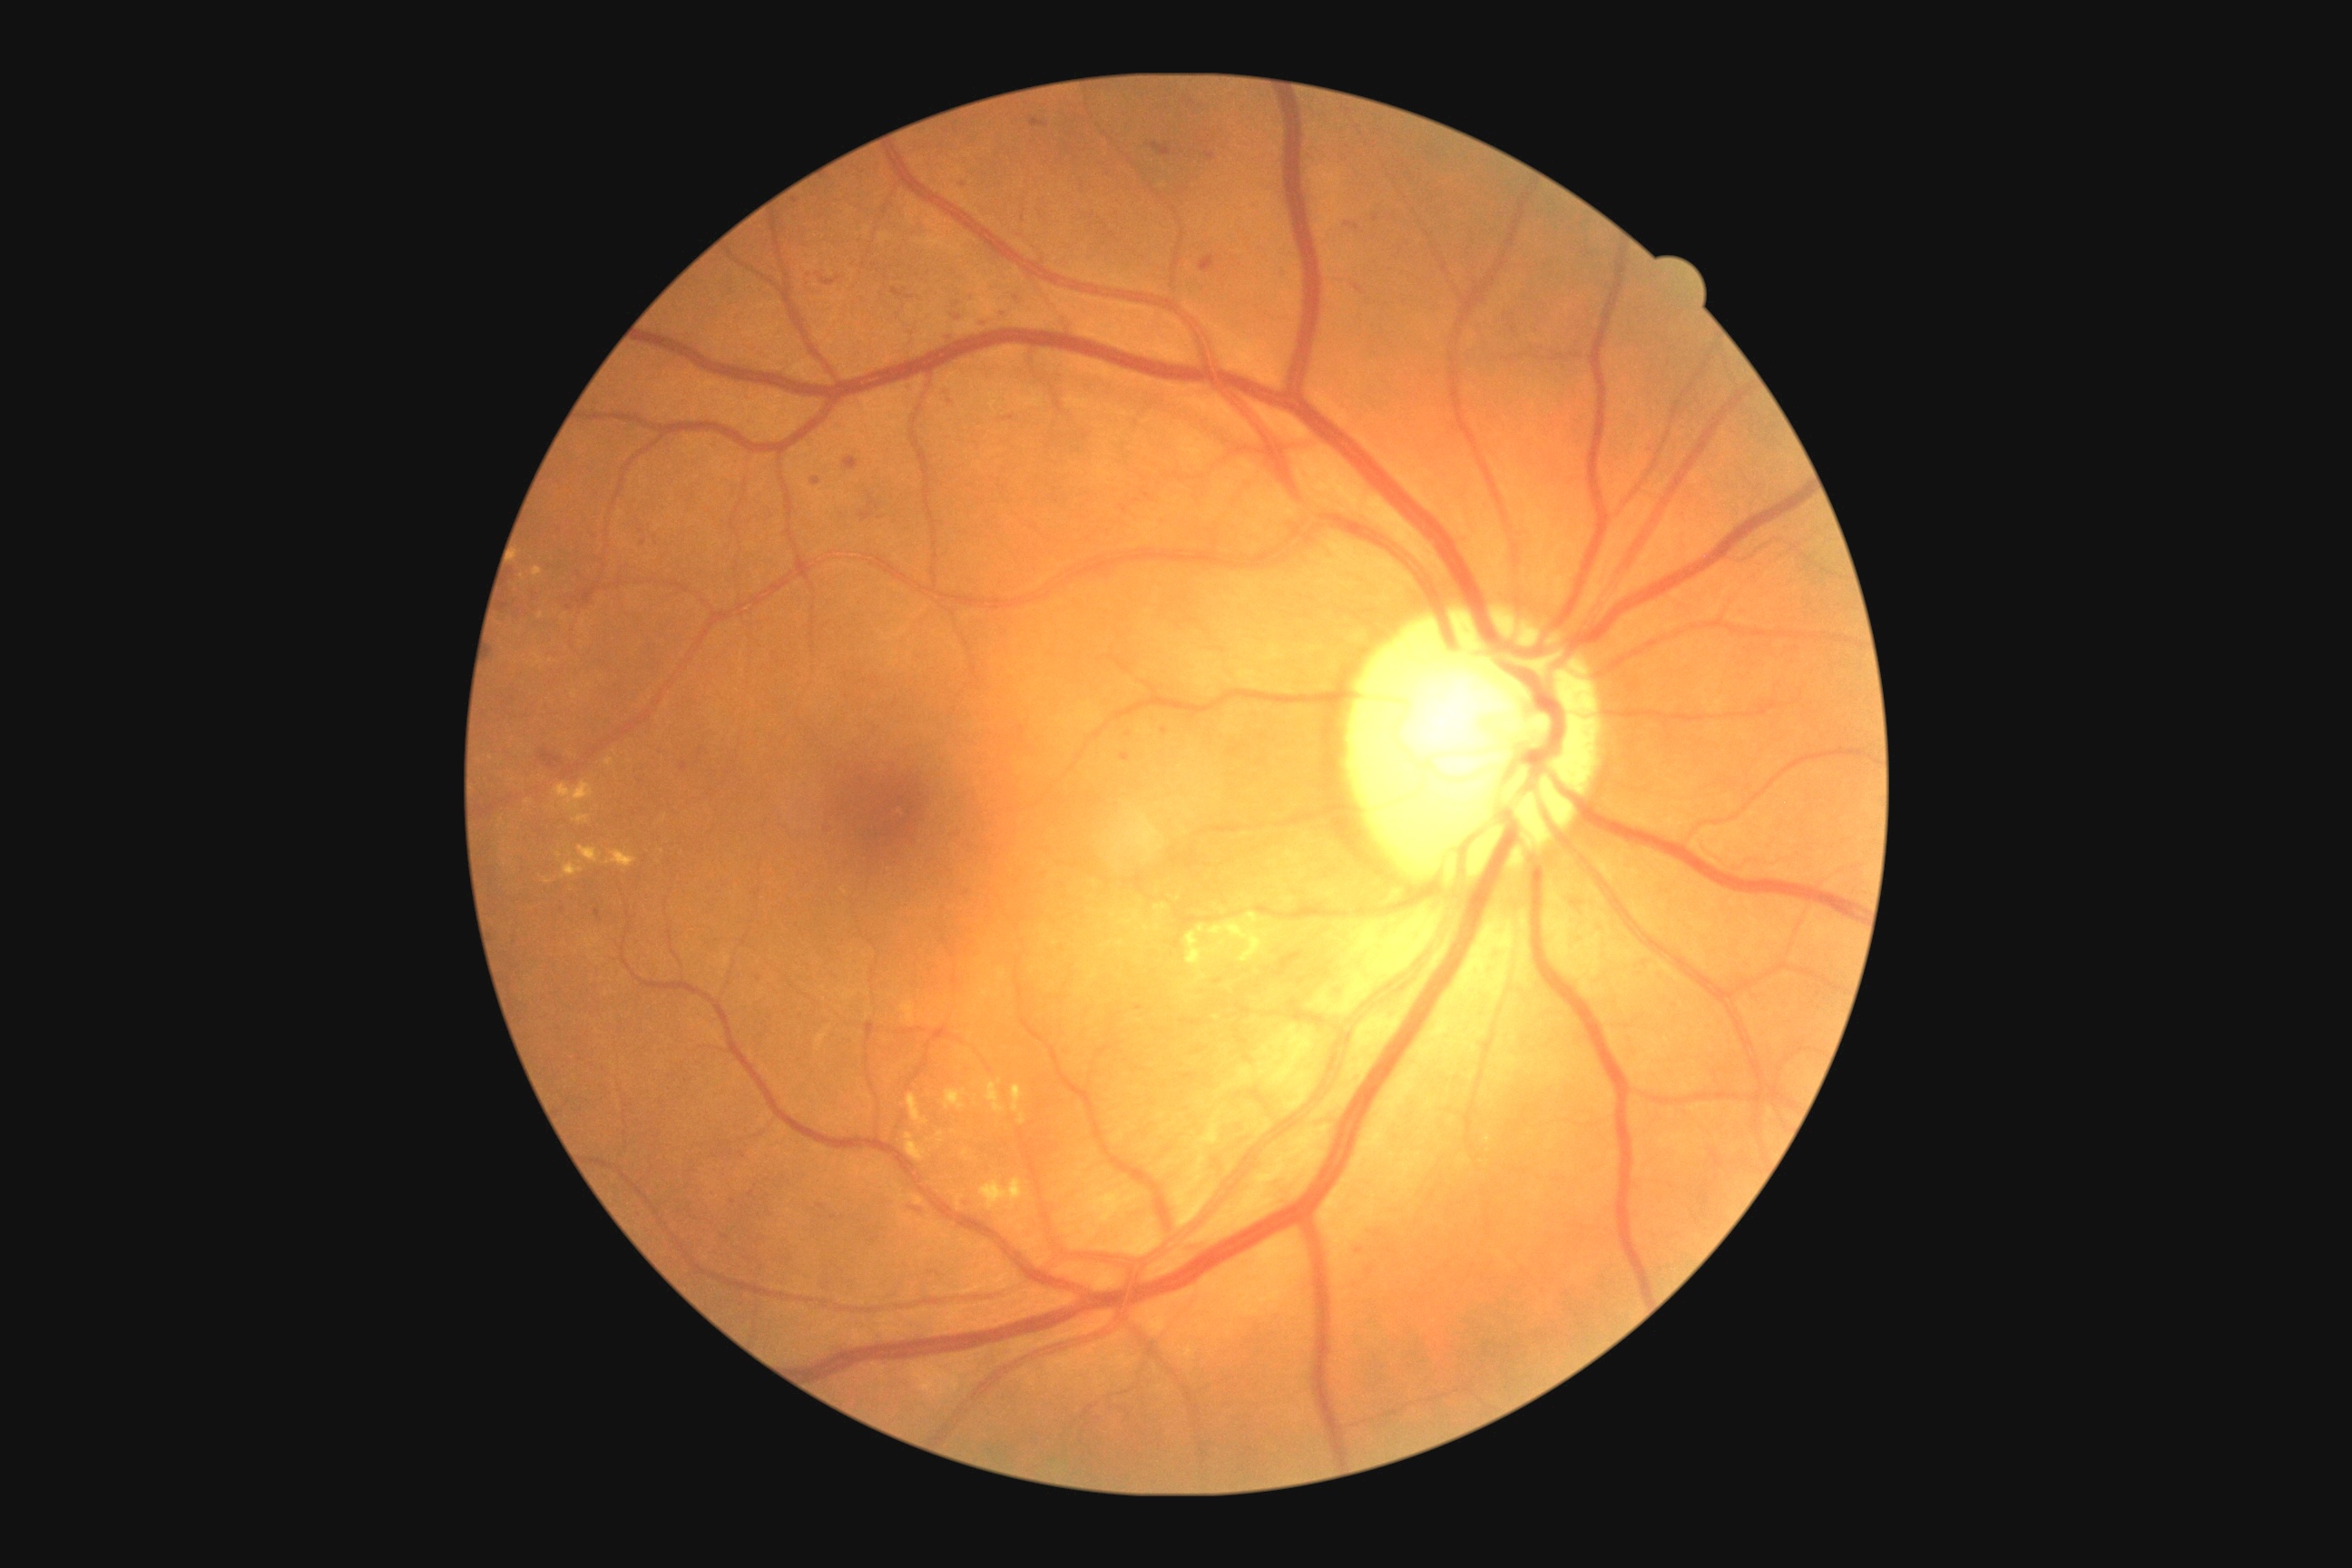

Diabetic retinopathy (DR) is grade 2 (moderate NPDR).
Hard exudates (EXs) include 906,1093,928,1124 | 578,847,602,865 | 605,850,636,868 | 533,567,544,578 | 538,612,544,620 | 979,1179,1024,1211 | 1019,1113,1026,1124 | 562,863,583,877 | 937,1132,945,1137 | 554,781,594,810.
Small EXs approximately at (x=1223, y=942).
Hemorrhages (HEs) include 1024,308,1032,315 | 977,304,1008,331 | 540,750,564,770 | 818,275,841,286 | 910,1208,923,1213 | 830,1215,838,1220 | 1206,153,1215,161 | 1500,309,1520,338 | 594,908,602,921 | 959,1195,975,1208 | 1032,119,1048,128.
Small HEs approximately at (x=882, y=518) | (x=1360, y=1251) | (x=743, y=1156) | (x=1138, y=1008) | (x=759, y=979) | (x=1348, y=224).